Infant wide-field retinal image · 1440x1080px
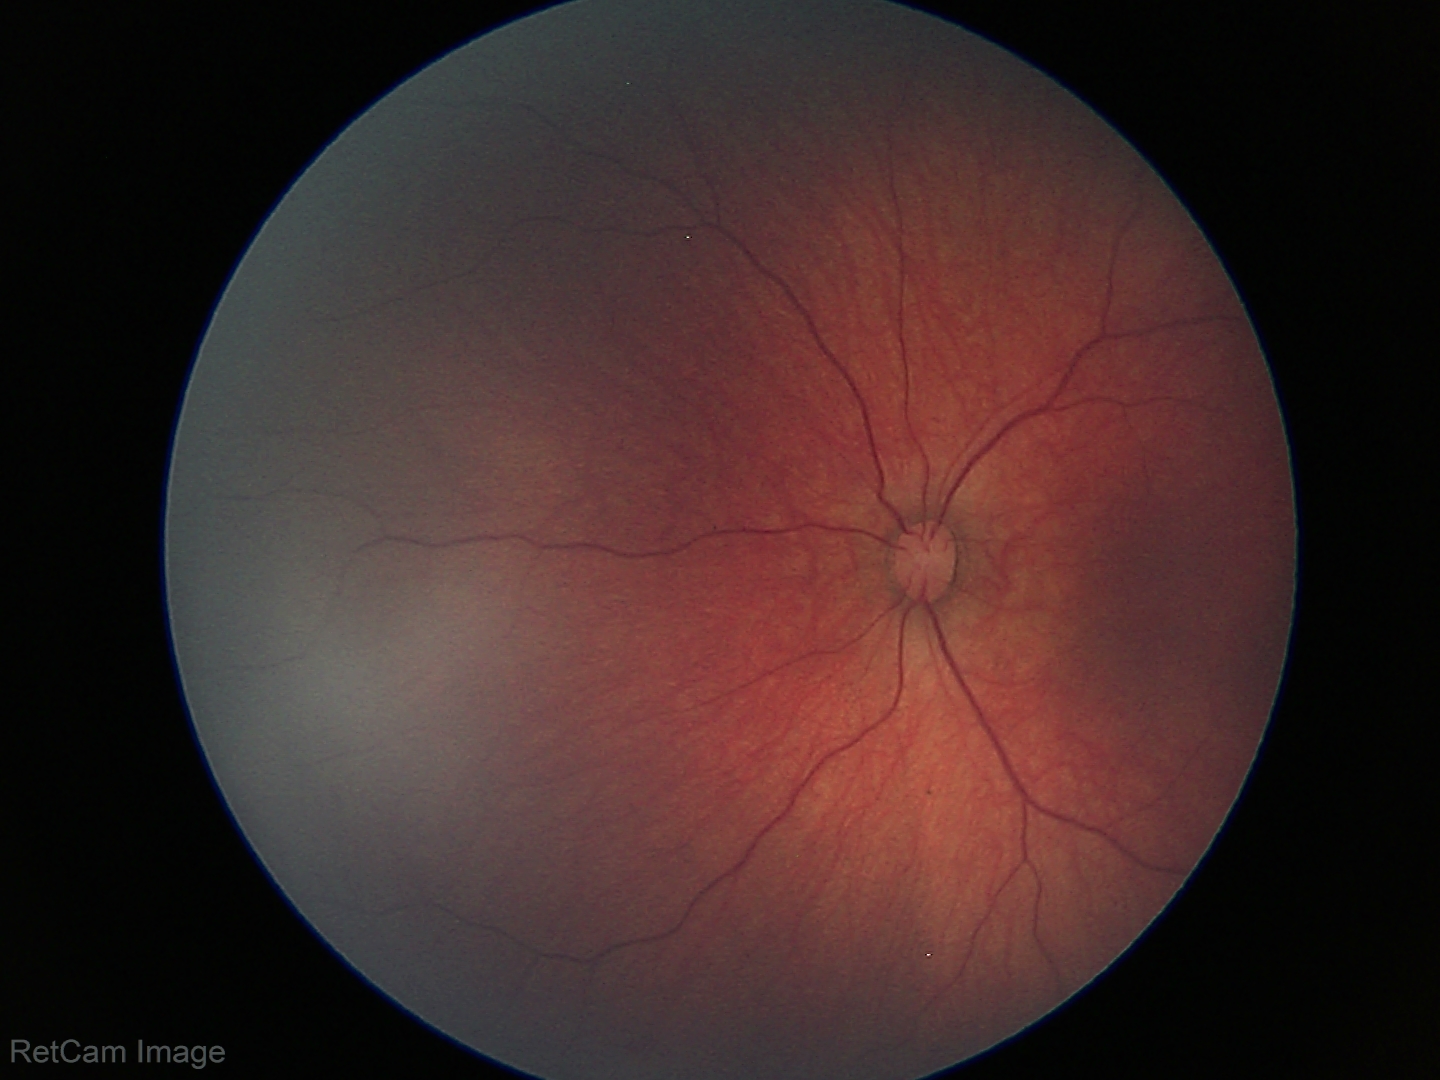

Screening: retinal hemorrhages.